45° FOV. Image size 2212x1659. Color fundus photograph.
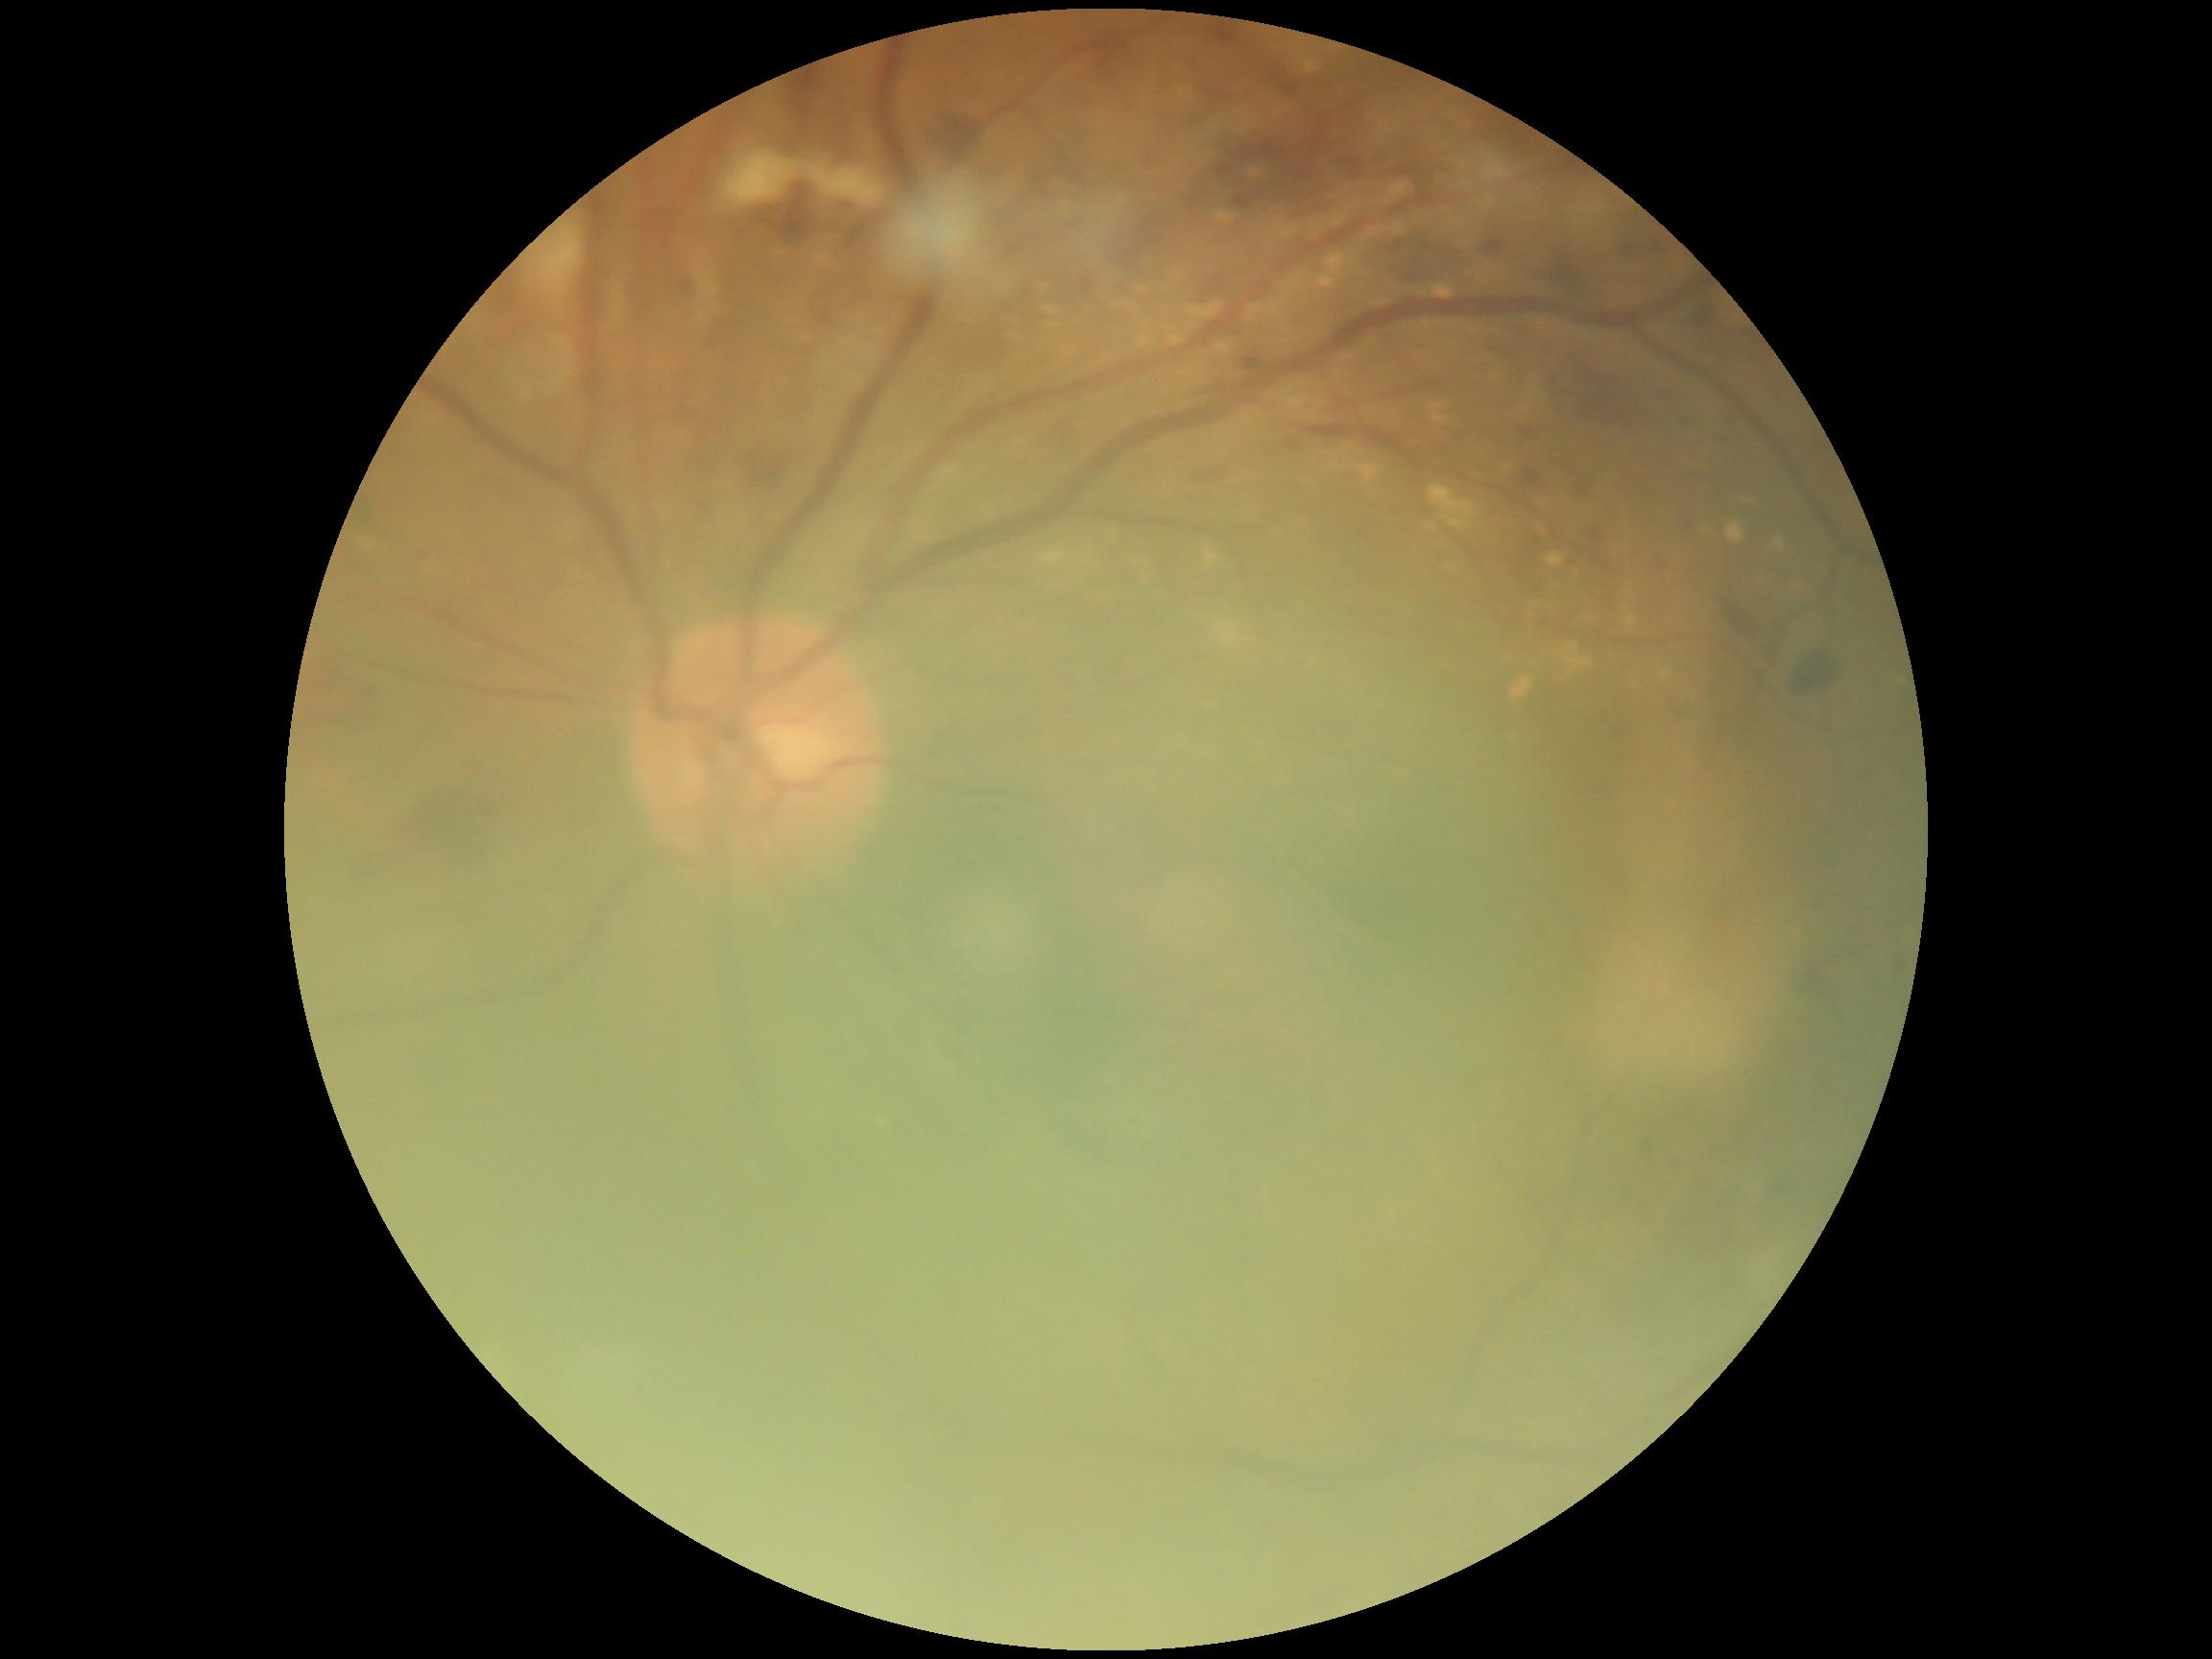

retinopathy grade = 2 (moderate NPDR).